Acquired with a NIDEK AFC-230; CFP
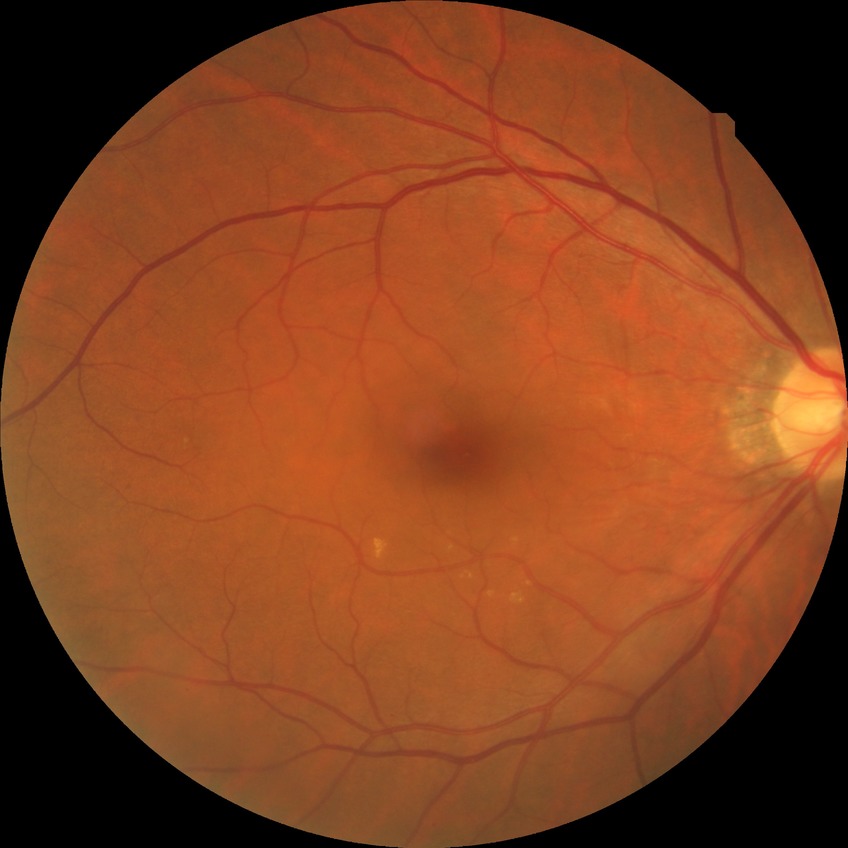

Diabetic retinopathy (DR) is NDR (no diabetic retinopathy).